Modified Davis grading. 45° FOV. Without pupil dilation:
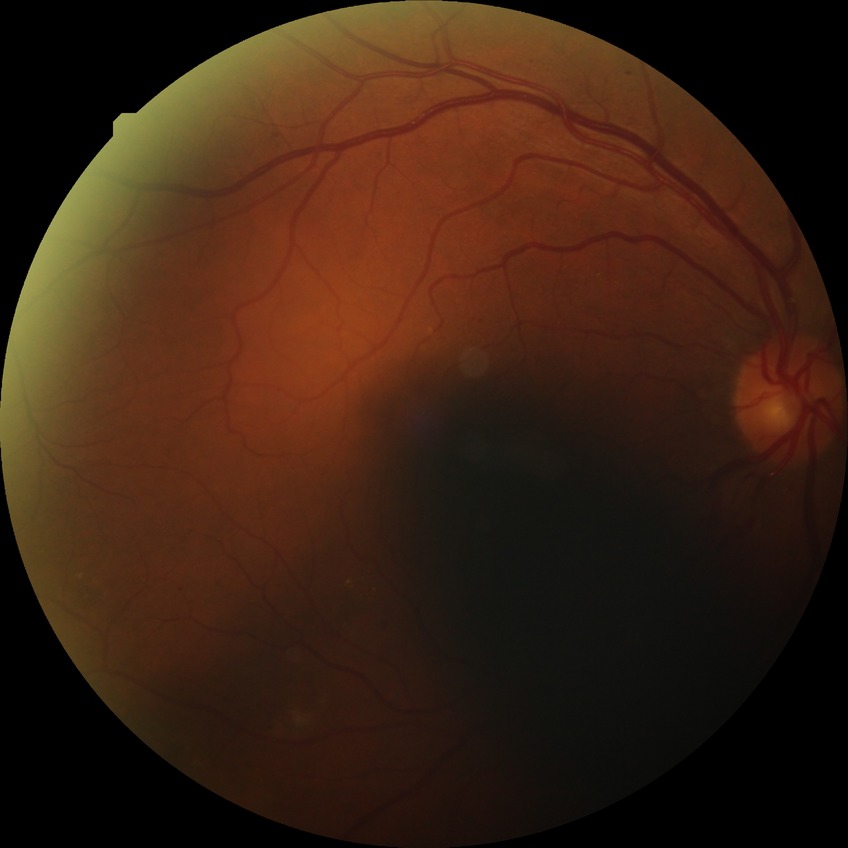 DR is SDR.